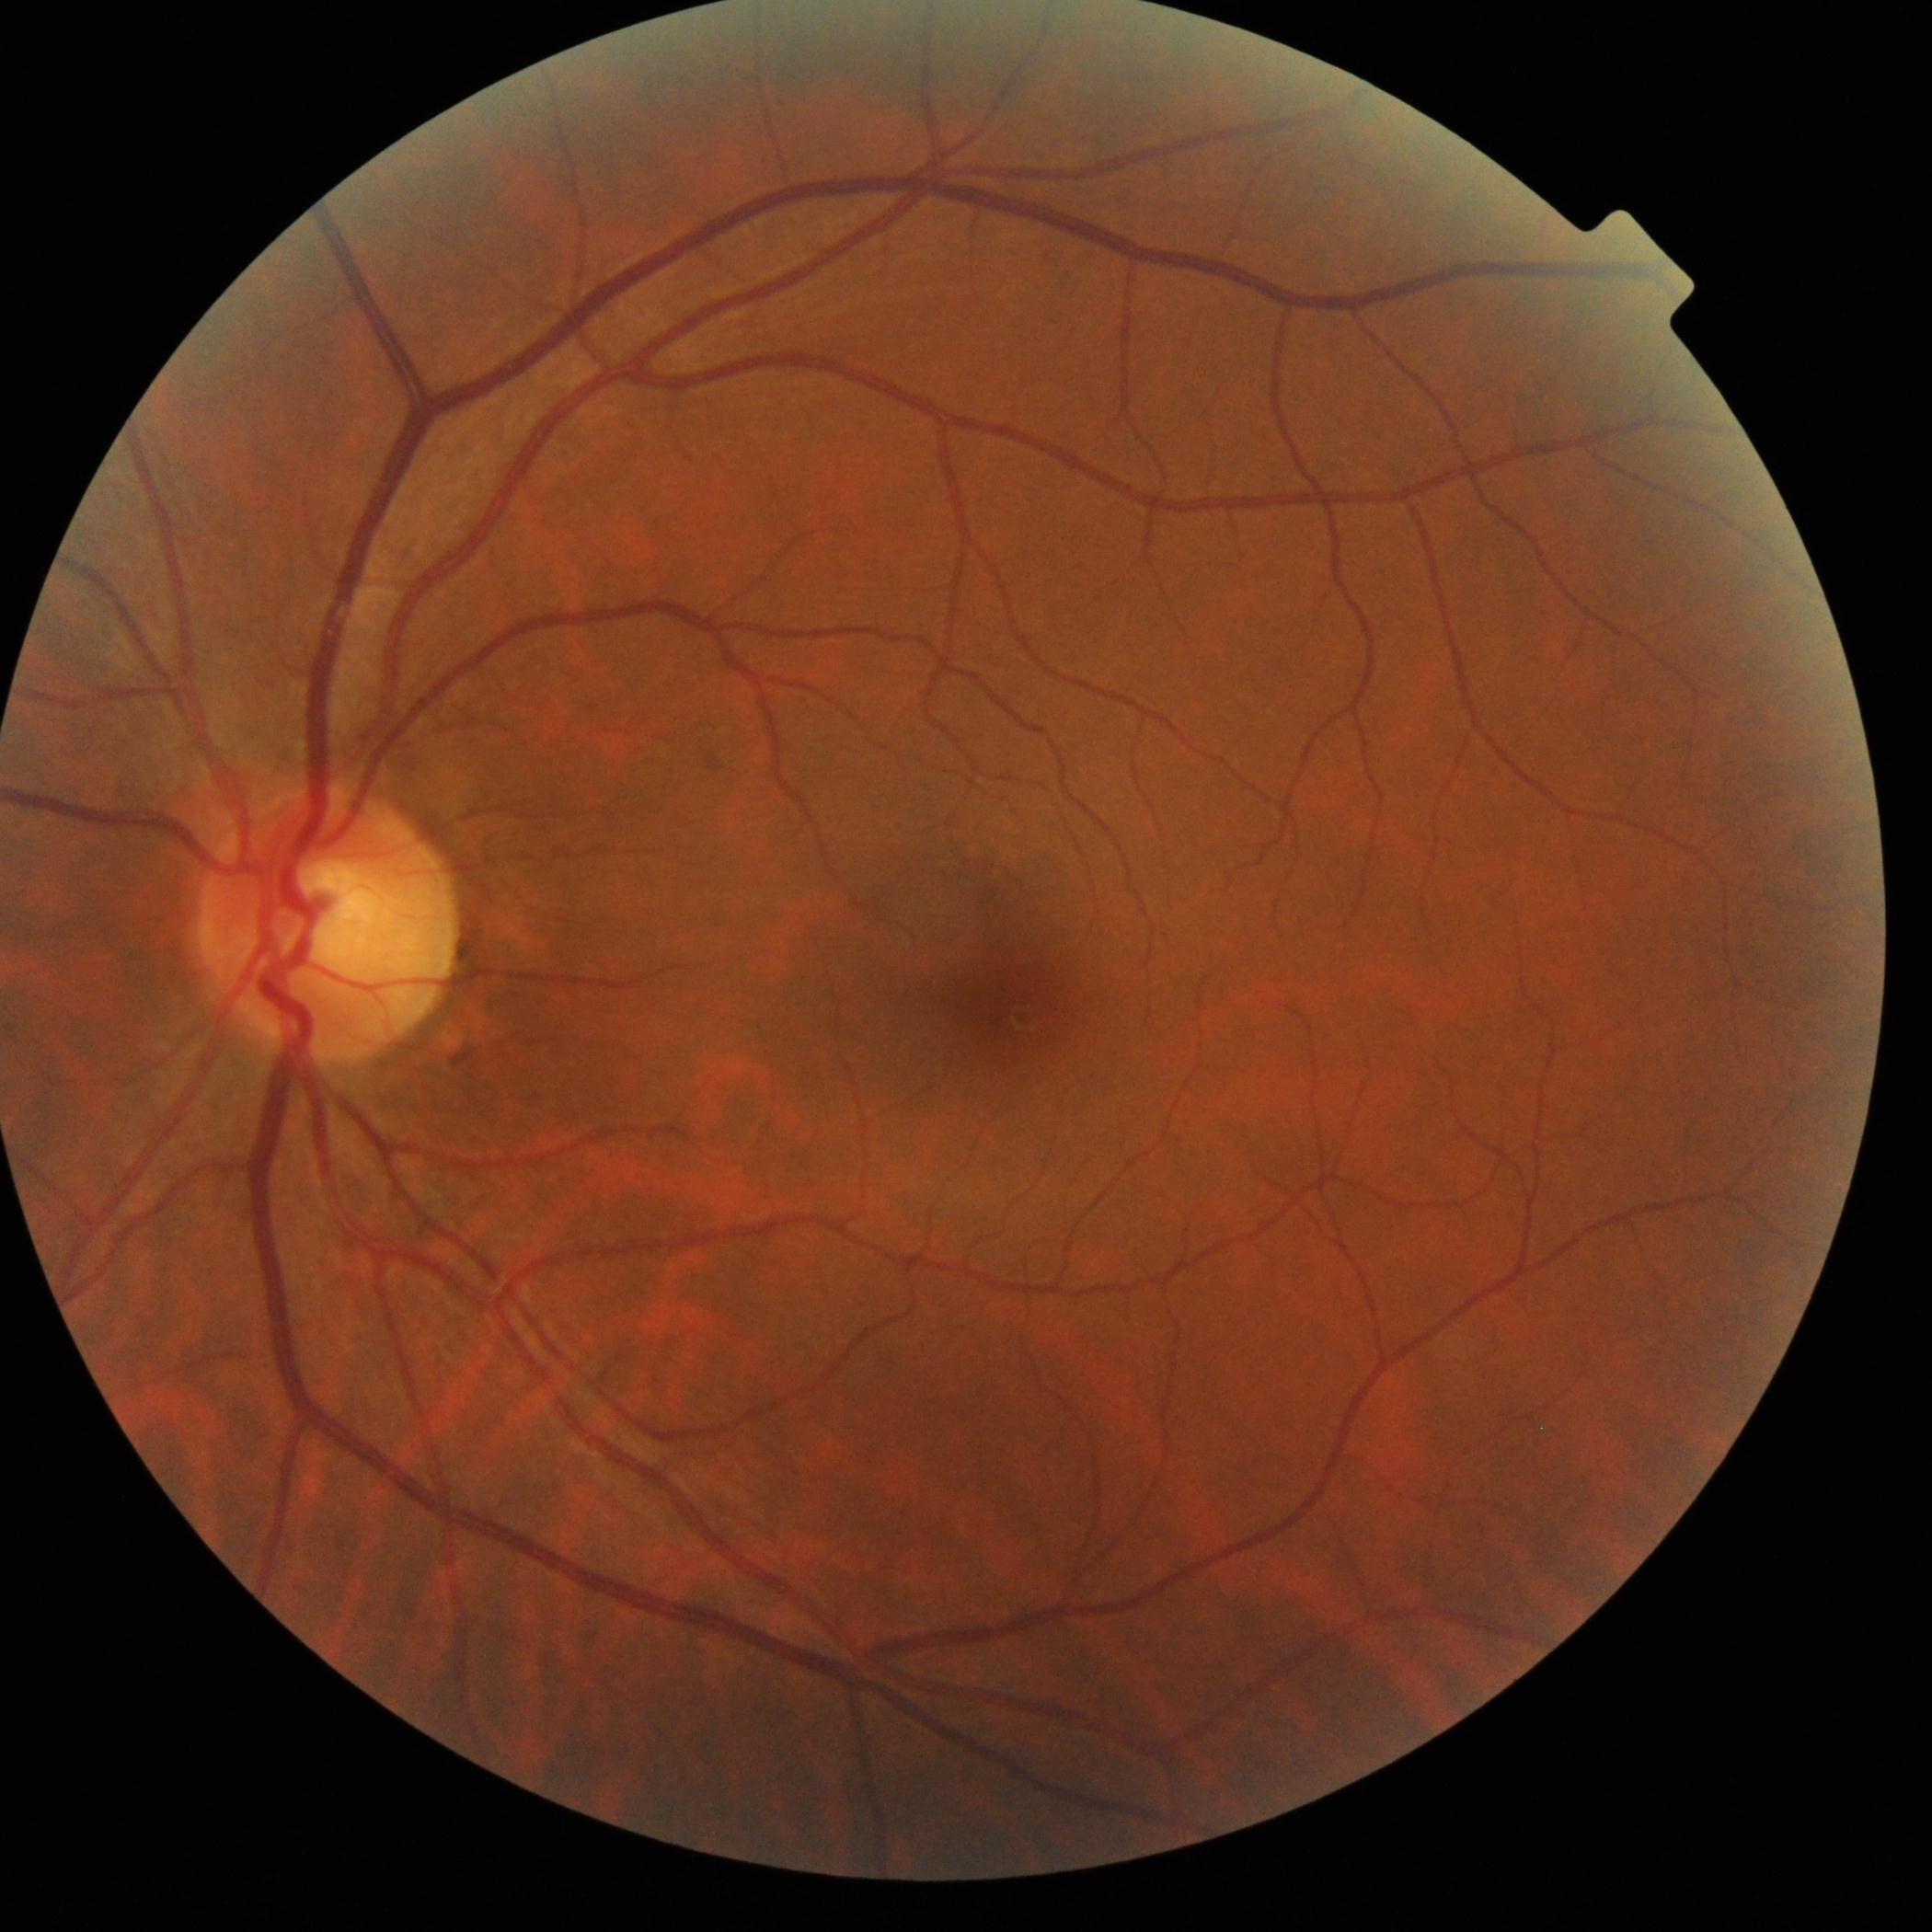

Diabetic retinopathy severity: 0/4.